100° field of view (Phoenix ICON) · pediatric retinal photograph (wide-field): 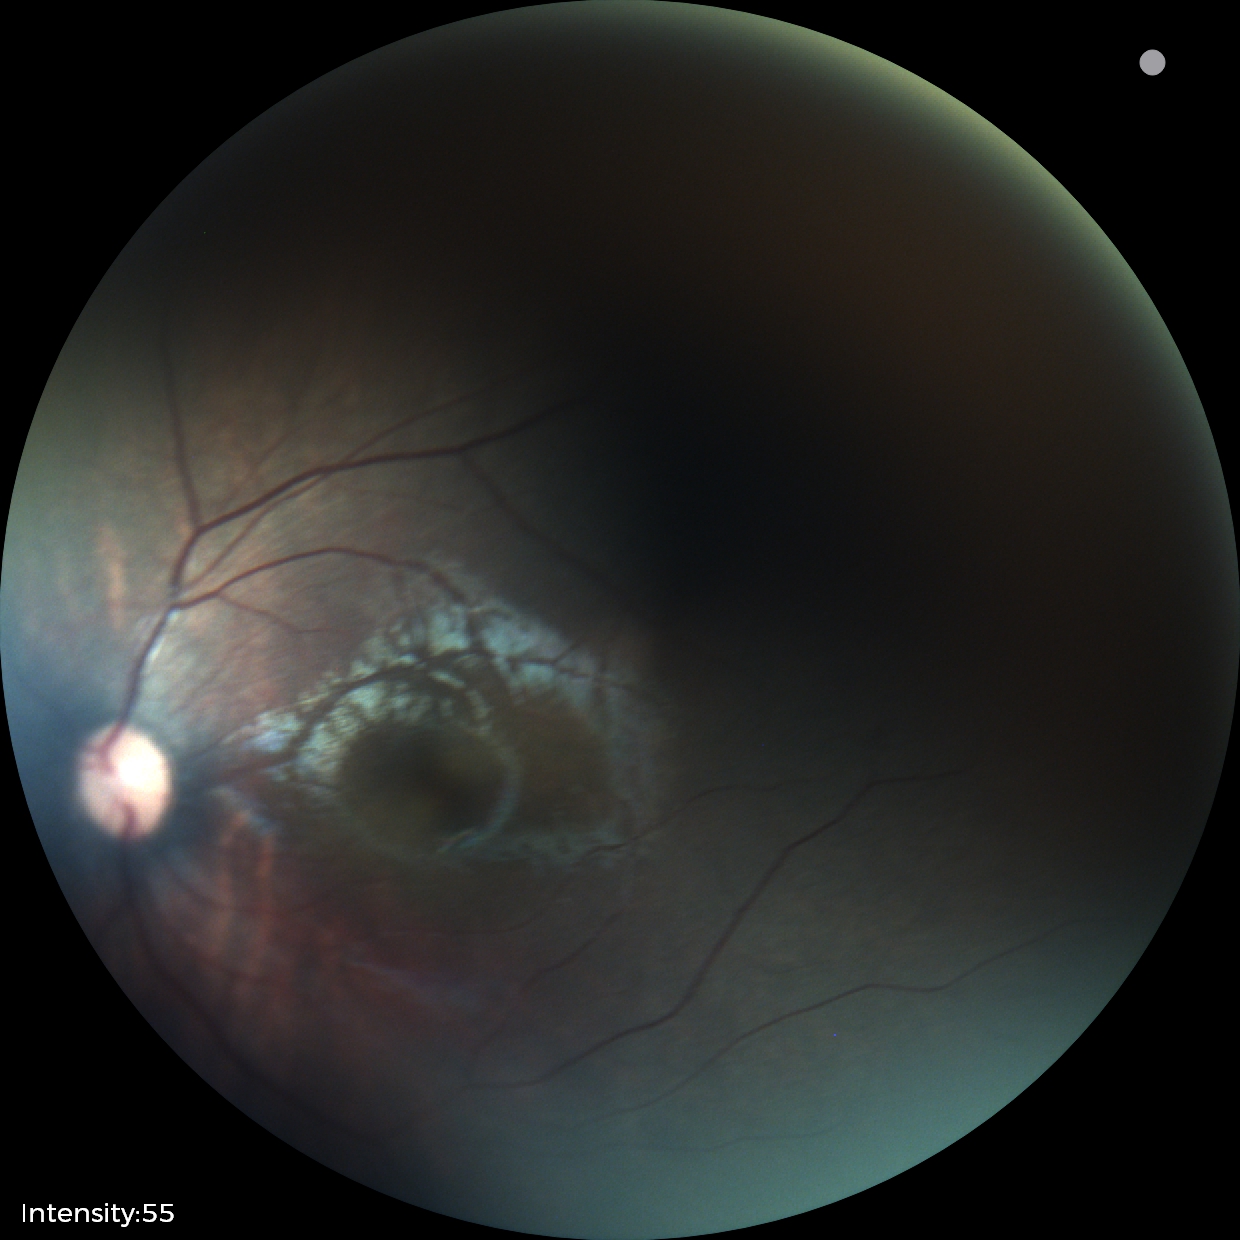 Assessment = normal.